Wide-field fundus photograph of an infant.
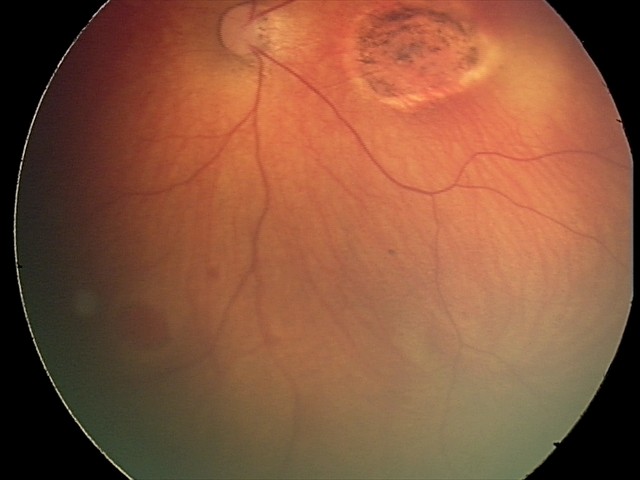 Examination diagnosed as toxoplasmosis chorioretinitis.